Non-mydriatic fundus camera · 240 x 240 pixels · CFP: 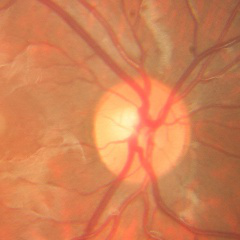
Q: What stage of glaucoma is present?
A: No glaucoma.